Camera: NIDEK AFC-230
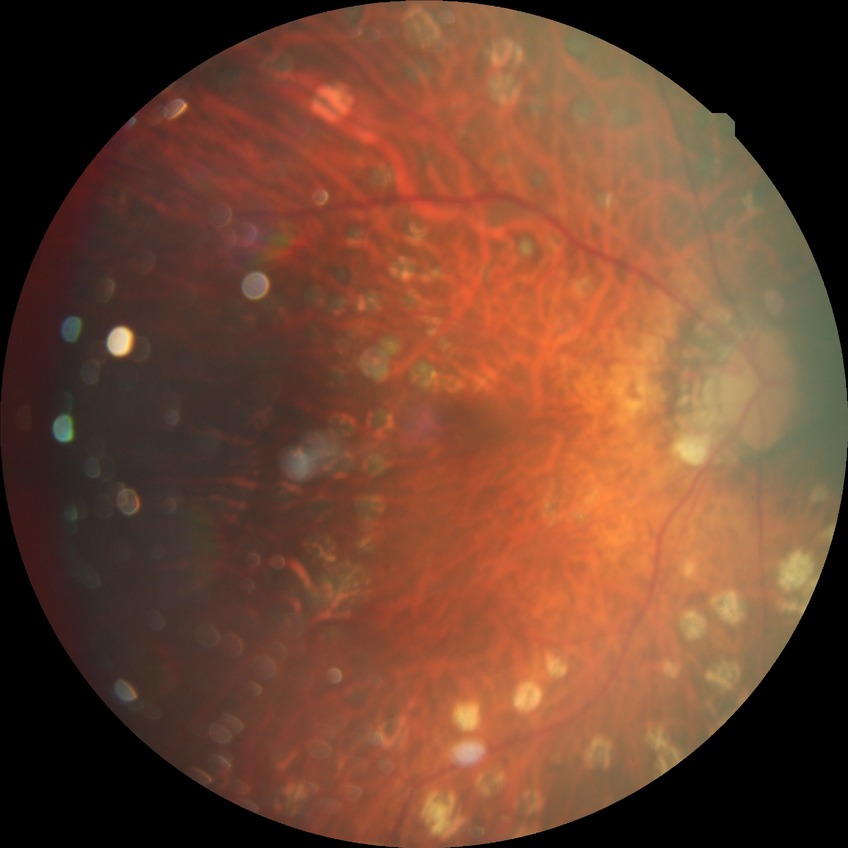 Diabetic retinopathy (DR) is PDR (proliferative diabetic retinopathy).